Color fundus photograph; 2352 by 1568 pixels:
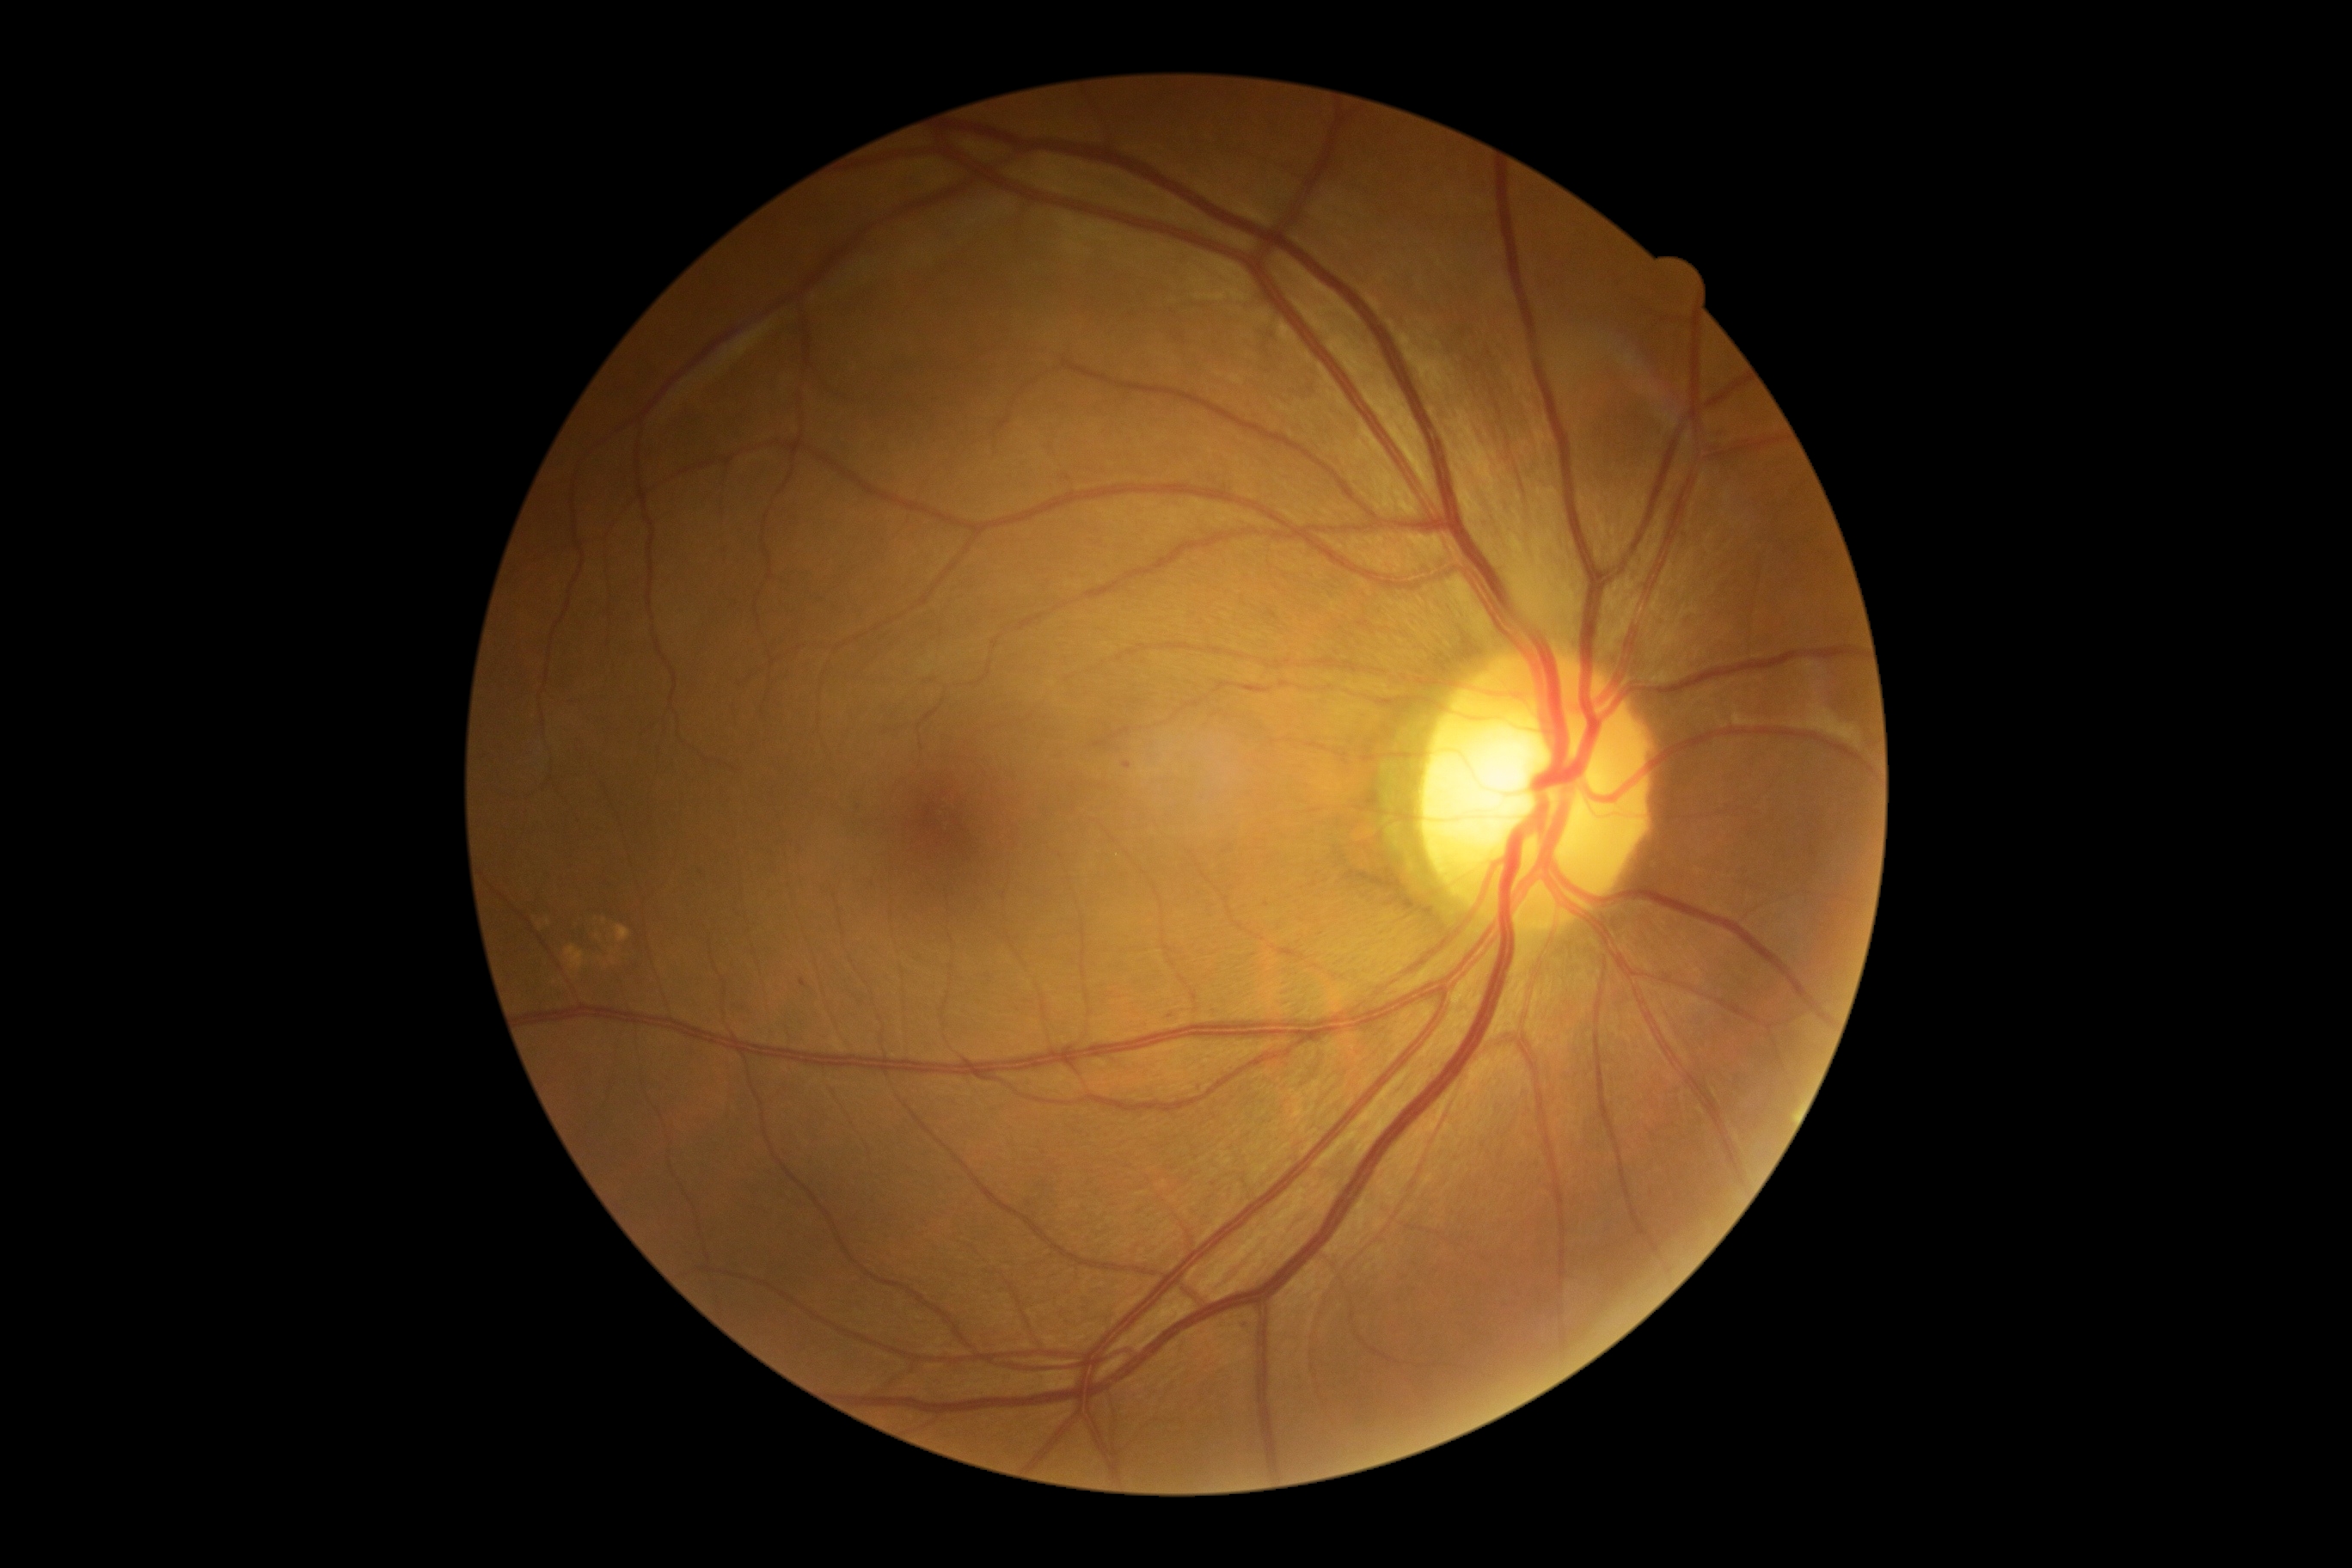

Retinopathy is 1/4.
The retinopathy is classified as non-proliferative diabetic retinopathy.